Without pupil dilation · graded on the modified Davis scale · color fundus photograph:
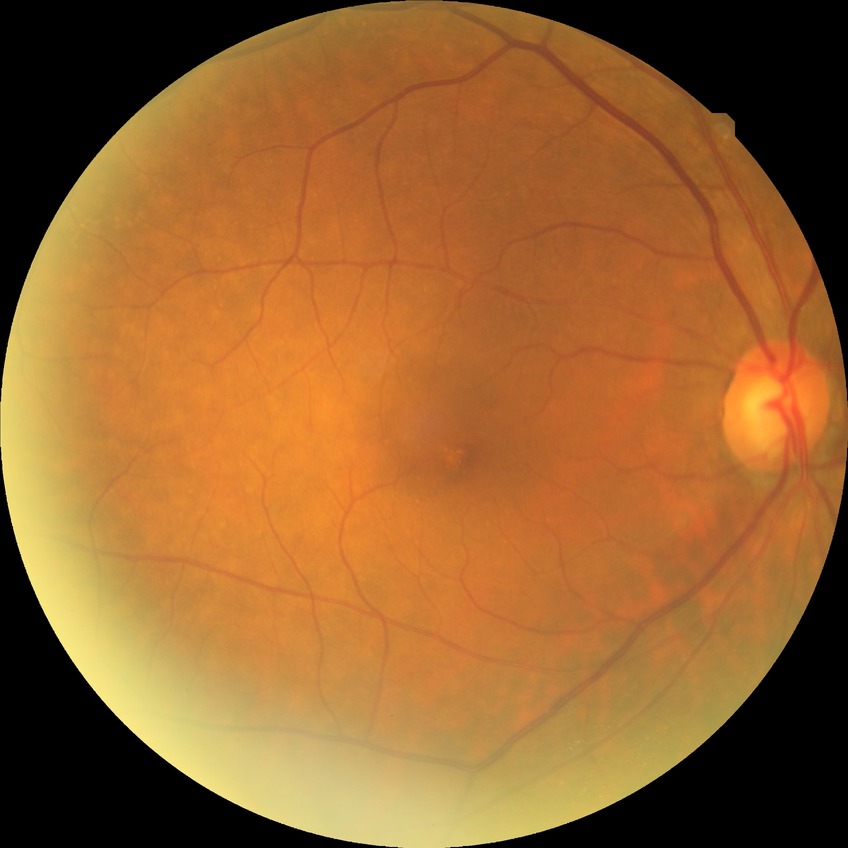 modified Davis grading = simple diabetic retinopathy.